512 x 512 pixels — 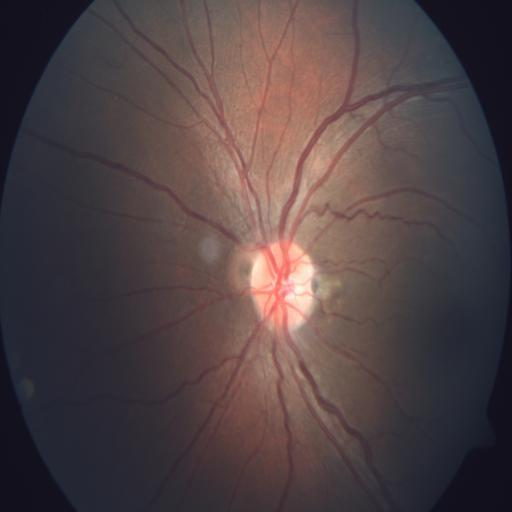 Color fundus photograph showing VS (vasculitis).